No pharmacologic dilation: 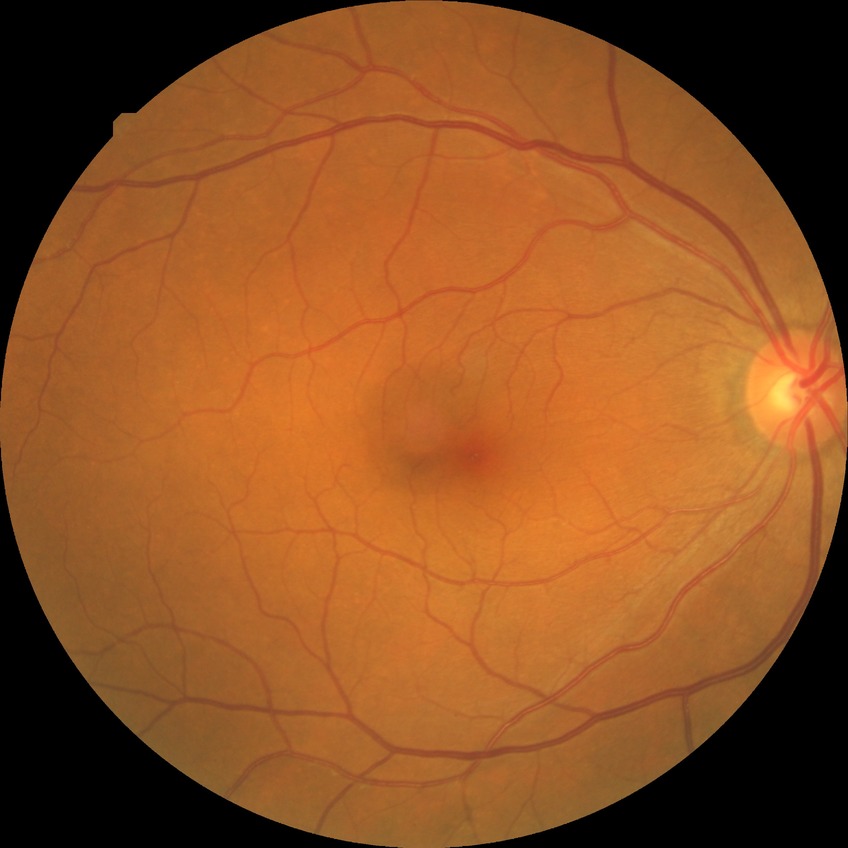
Findings:
– DR stage — NDR